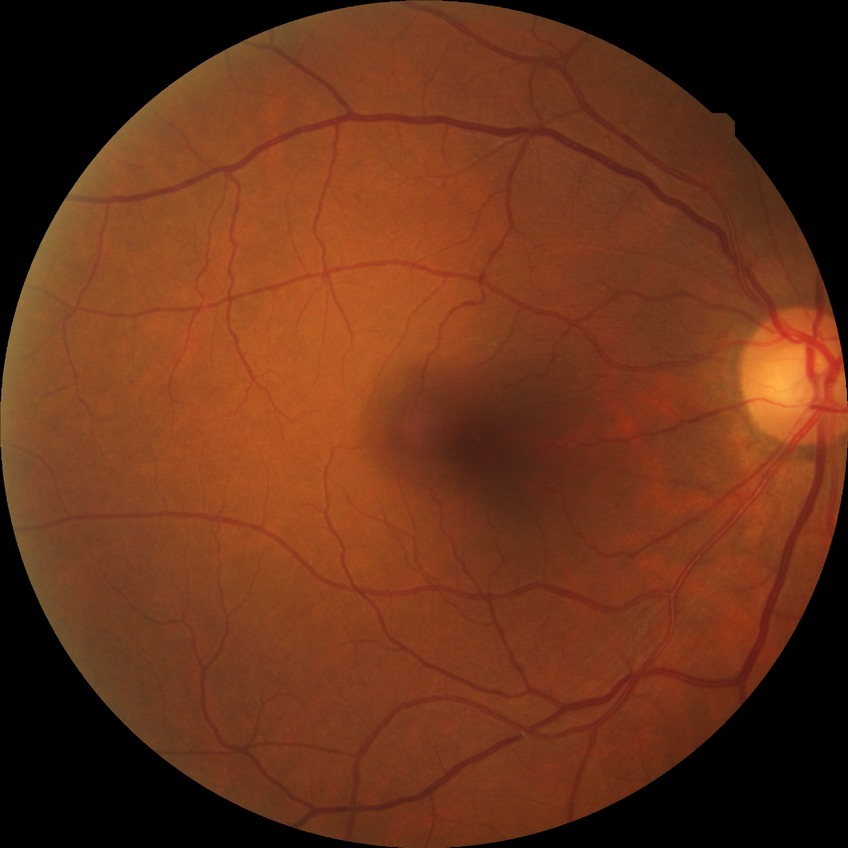
{
  "davis_grade": "NDR",
  "dr_impression": "no DR findings"
}